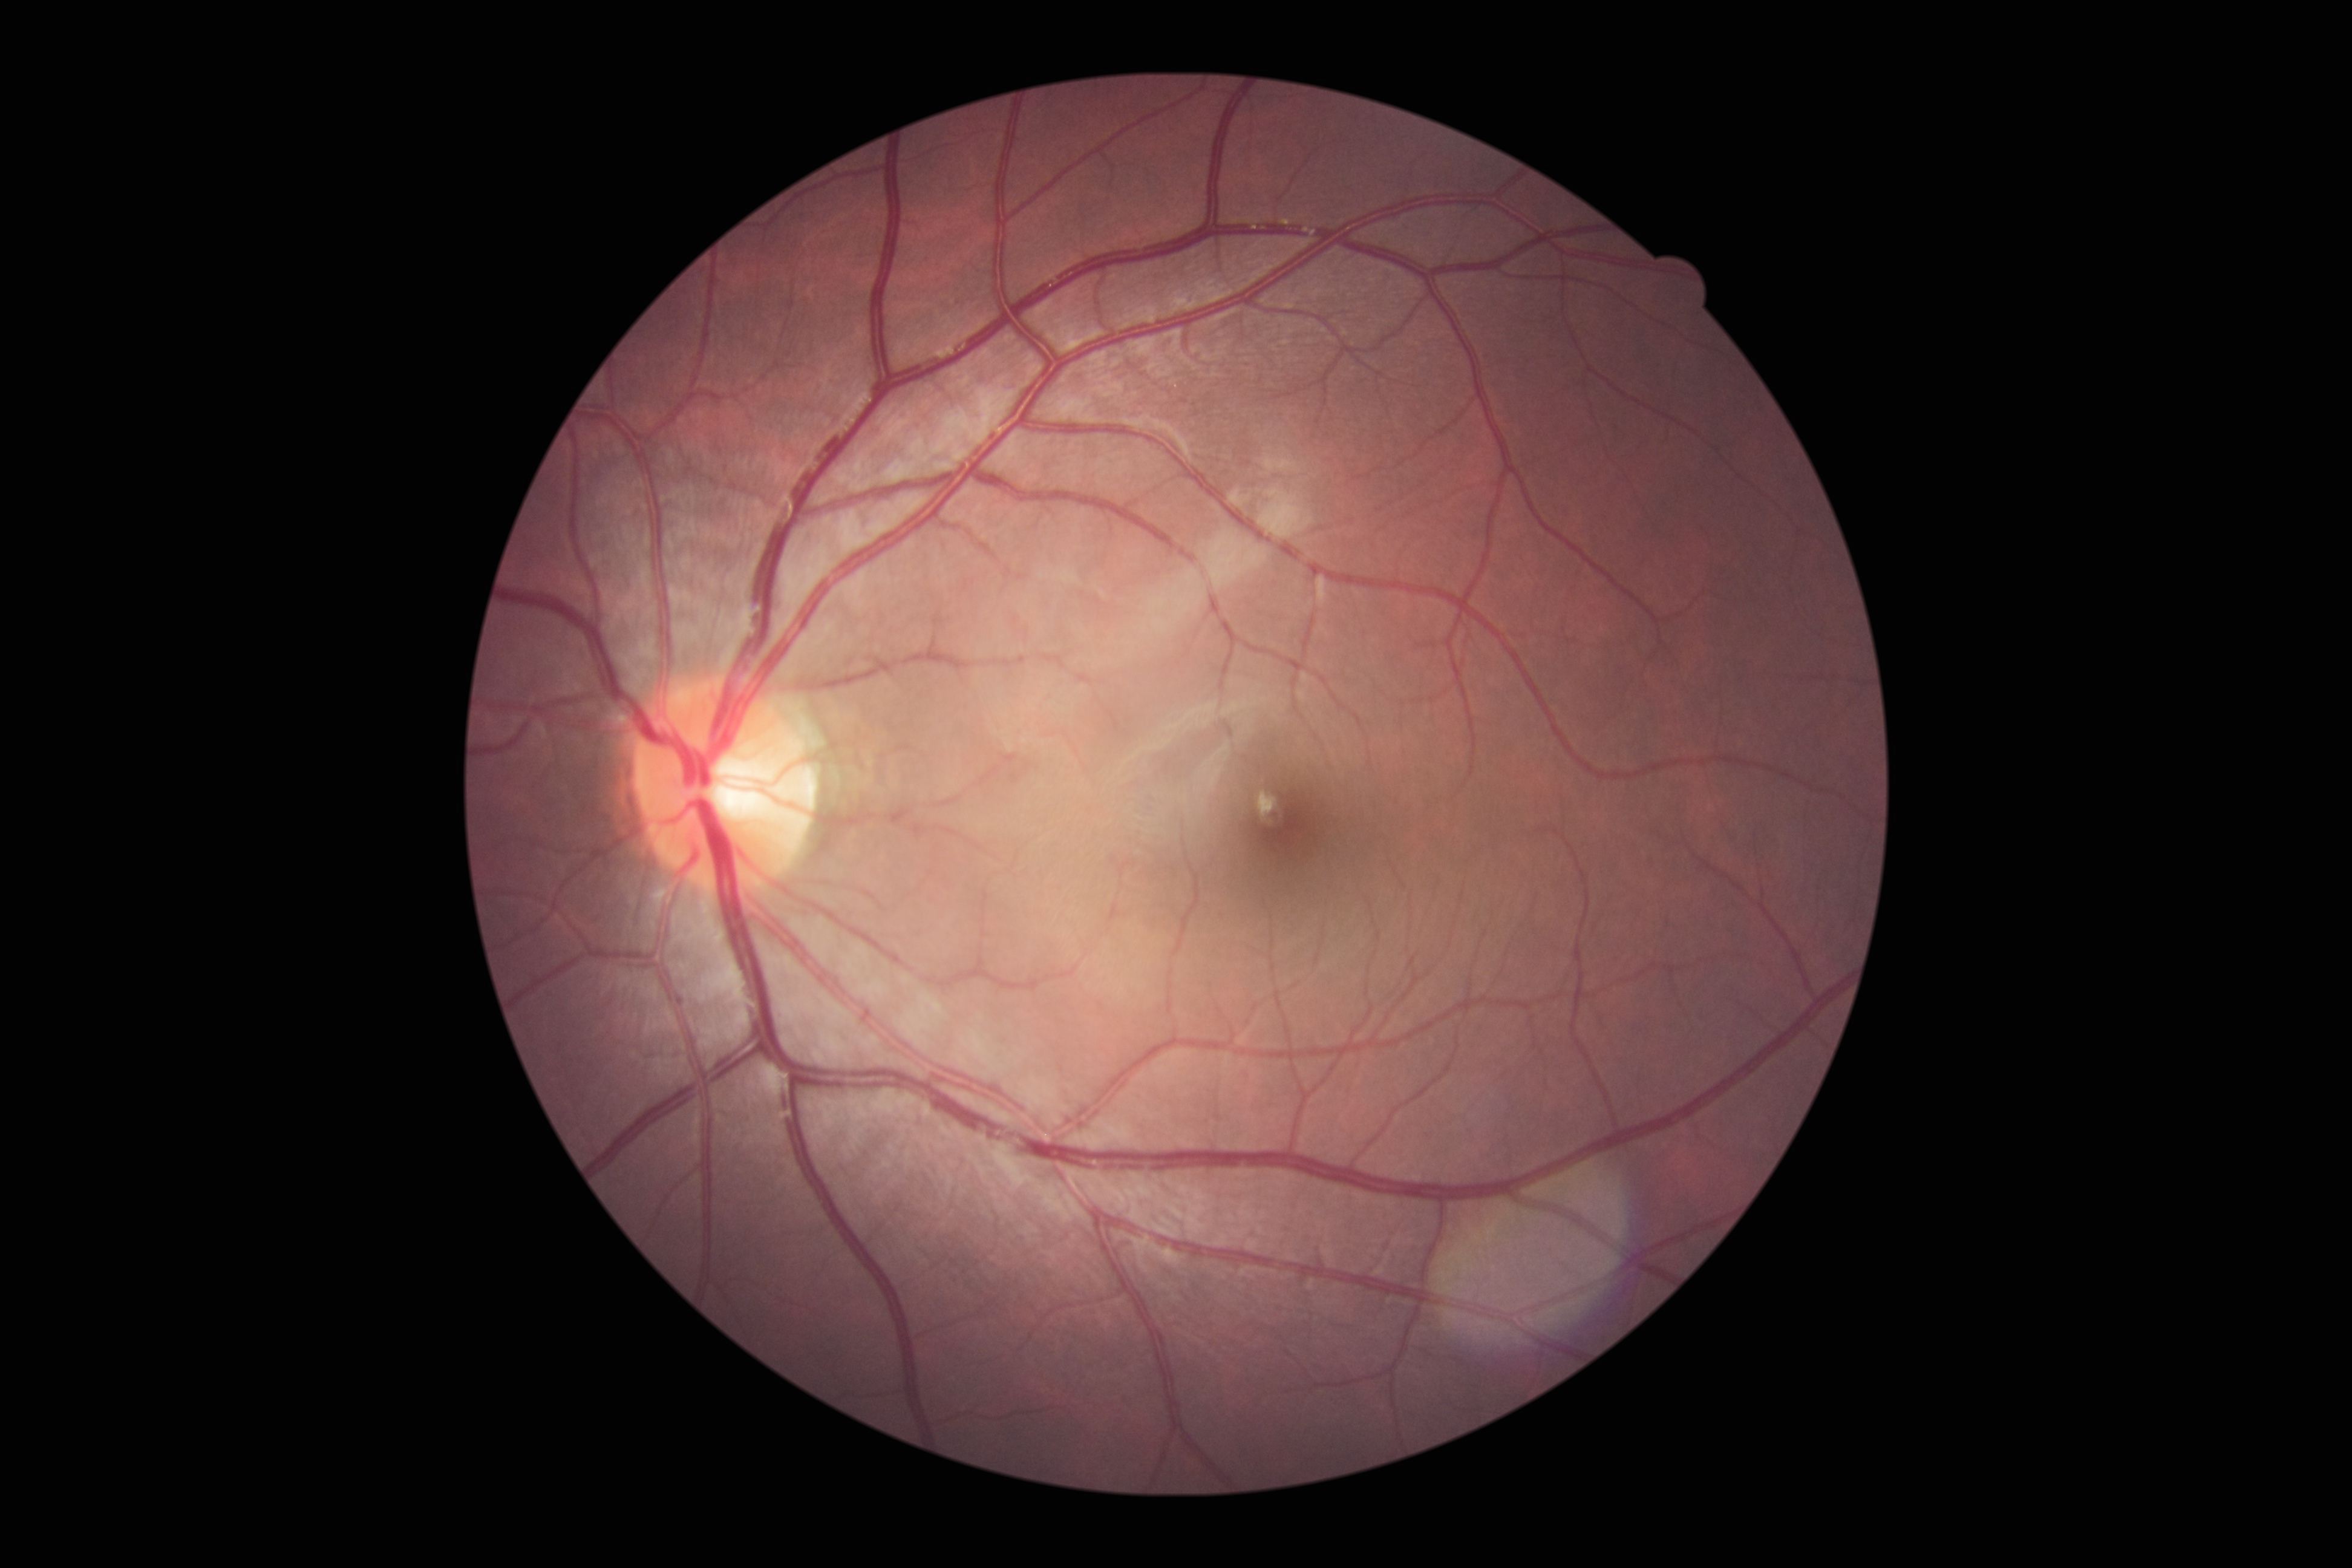
No apparent diabetic retinopathy.
DR grade: 0/4.